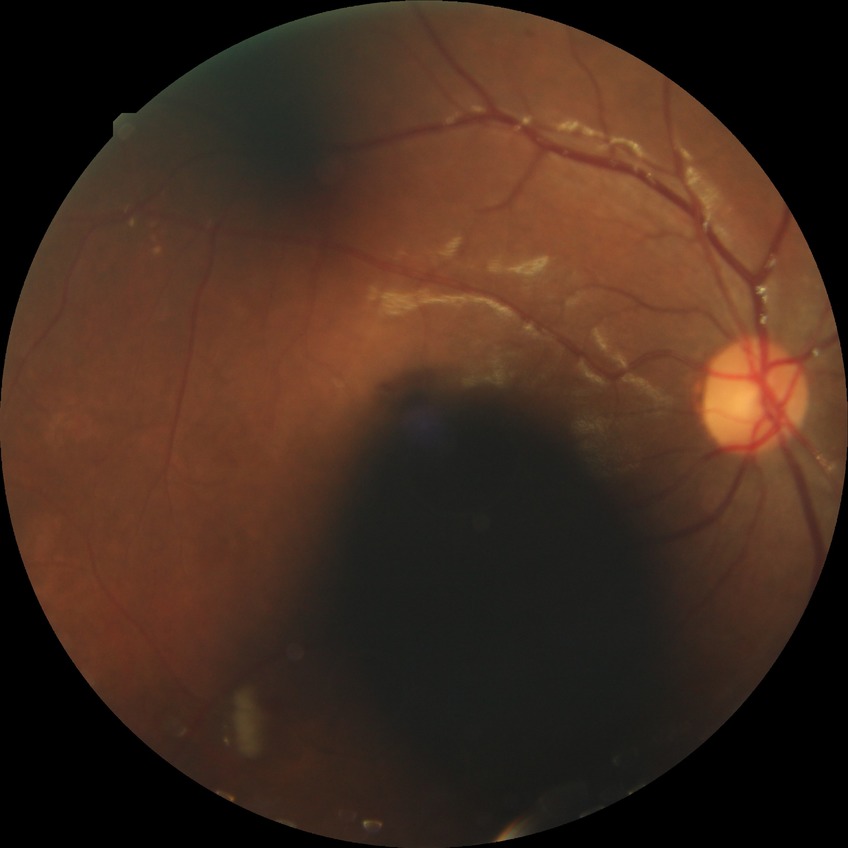 Diabetic retinopathy (DR) is PPDR (pre-proliferative diabetic retinopathy).